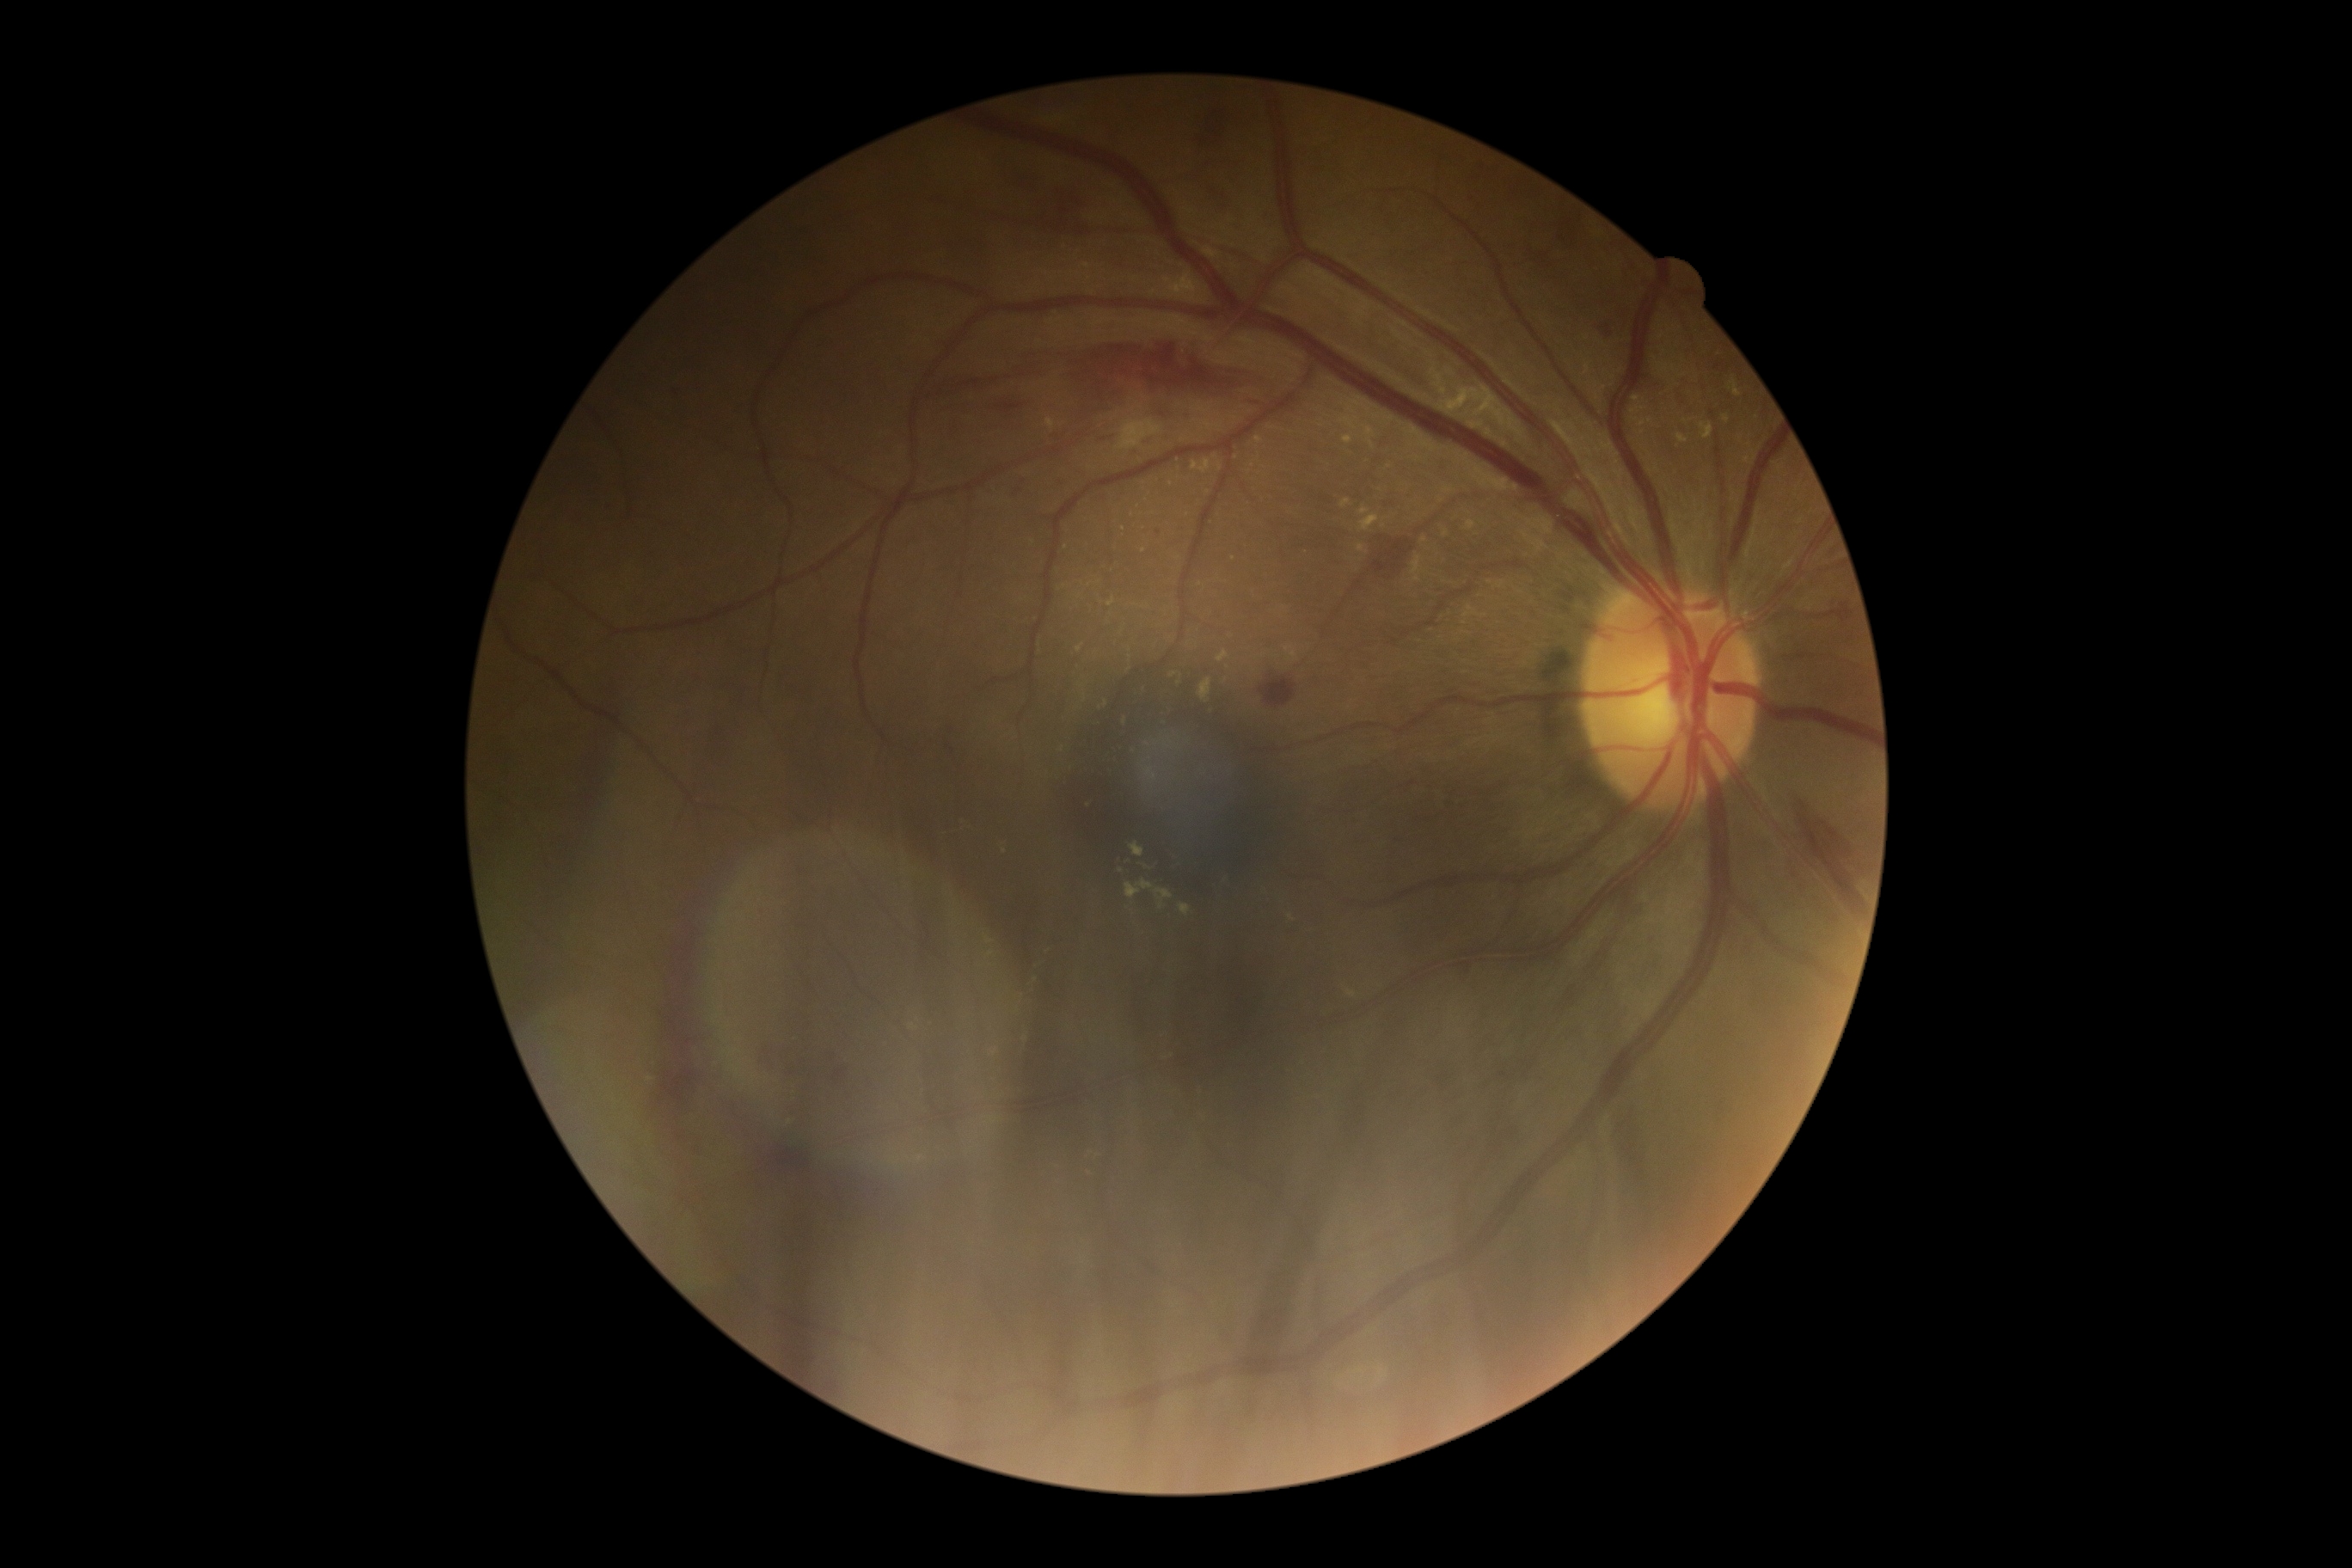 Findings:
* diabetic retinopathy (DR): 2